Graded on the modified Davis scale:
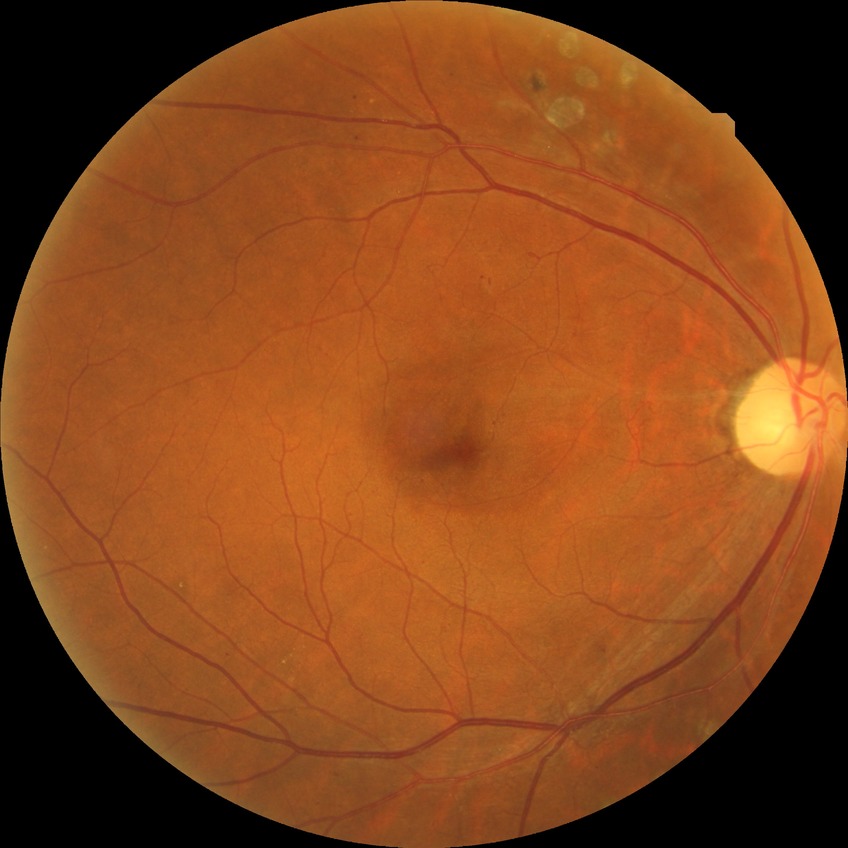

davis_grade: proliferative diabetic retinopathy